Pediatric wide-field fundus photograph.
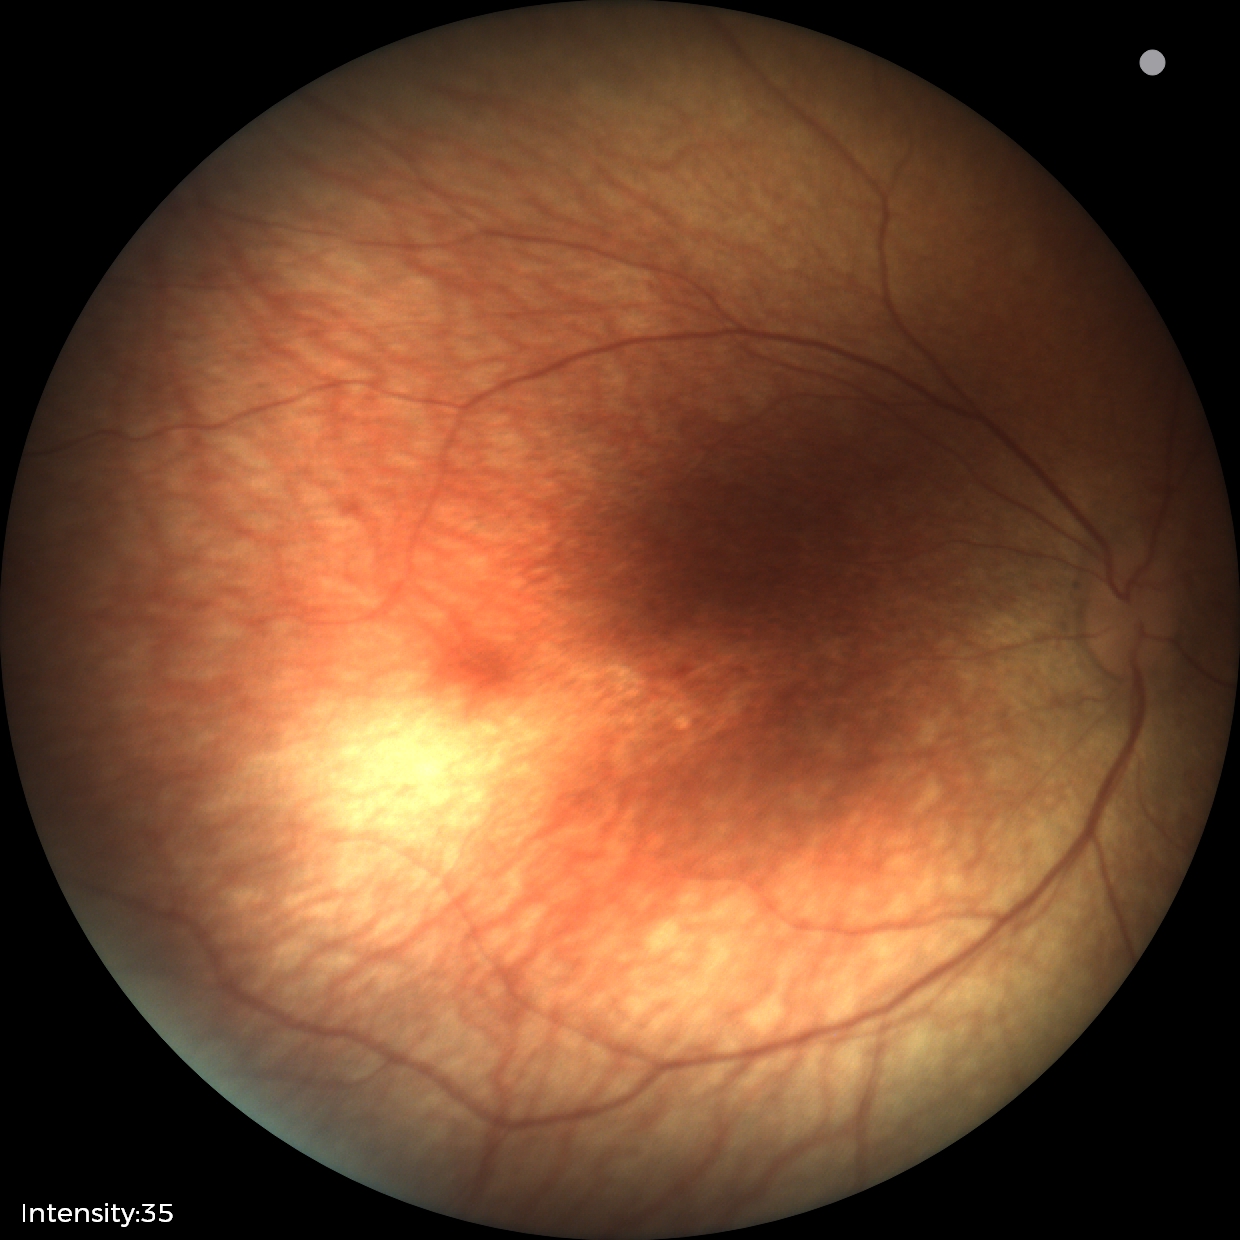 Screening examination with no abnormal retinal findings.